2352x1568: 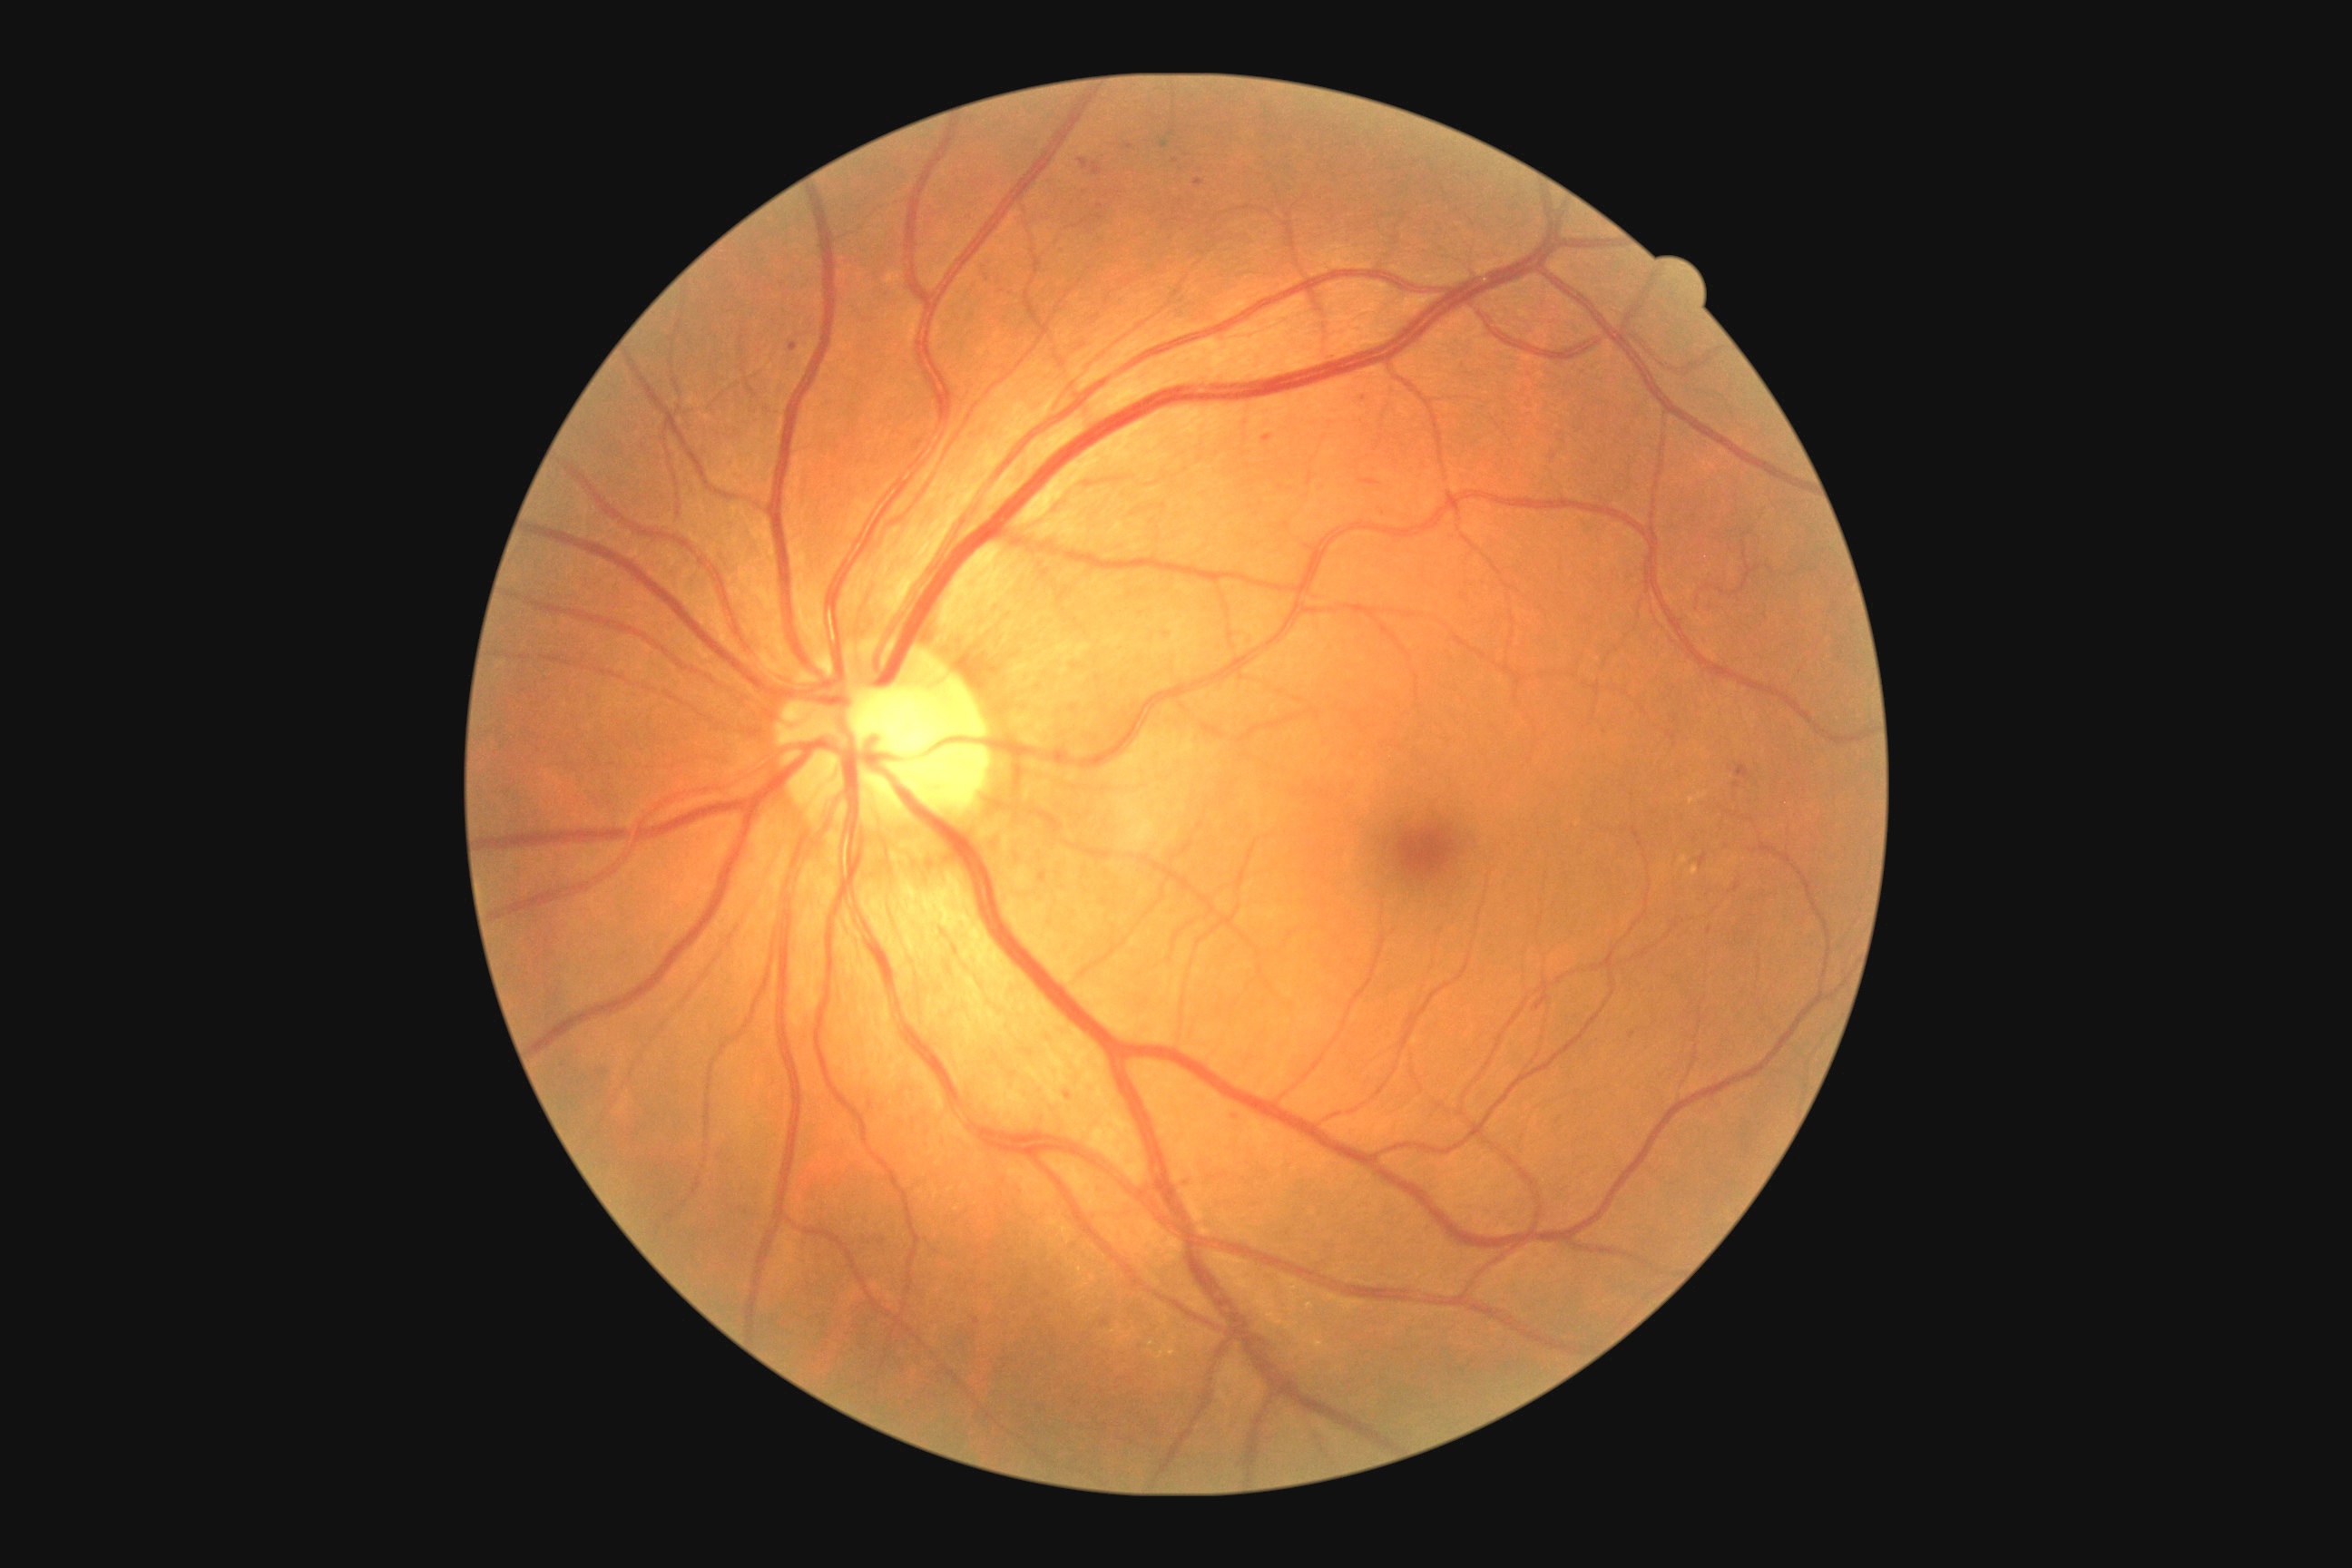 Retinopathy: 2/4. The retinopathy is classified as non-proliferative diabetic retinopathy.